45° field of view. Diabetic retinopathy graded by the modified Davis classification. 848x848px. Color fundus image. Nonmydriatic fundus photograph. Camera: NIDEK AFC-230: 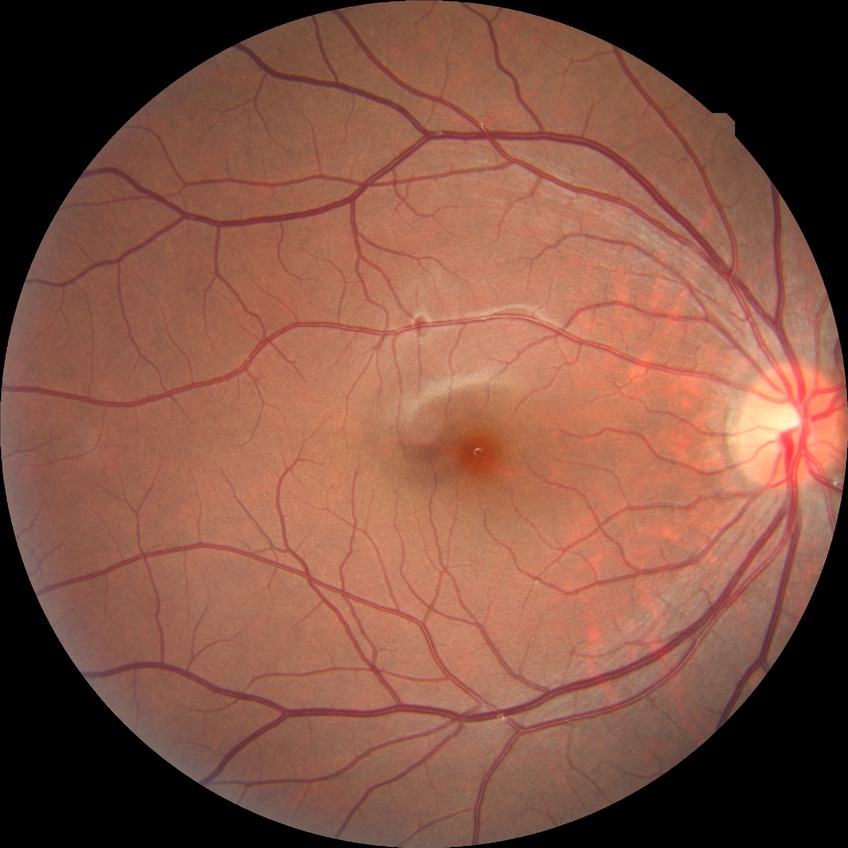

Diabetic retinopathy (DR): NDR (no diabetic retinopathy).